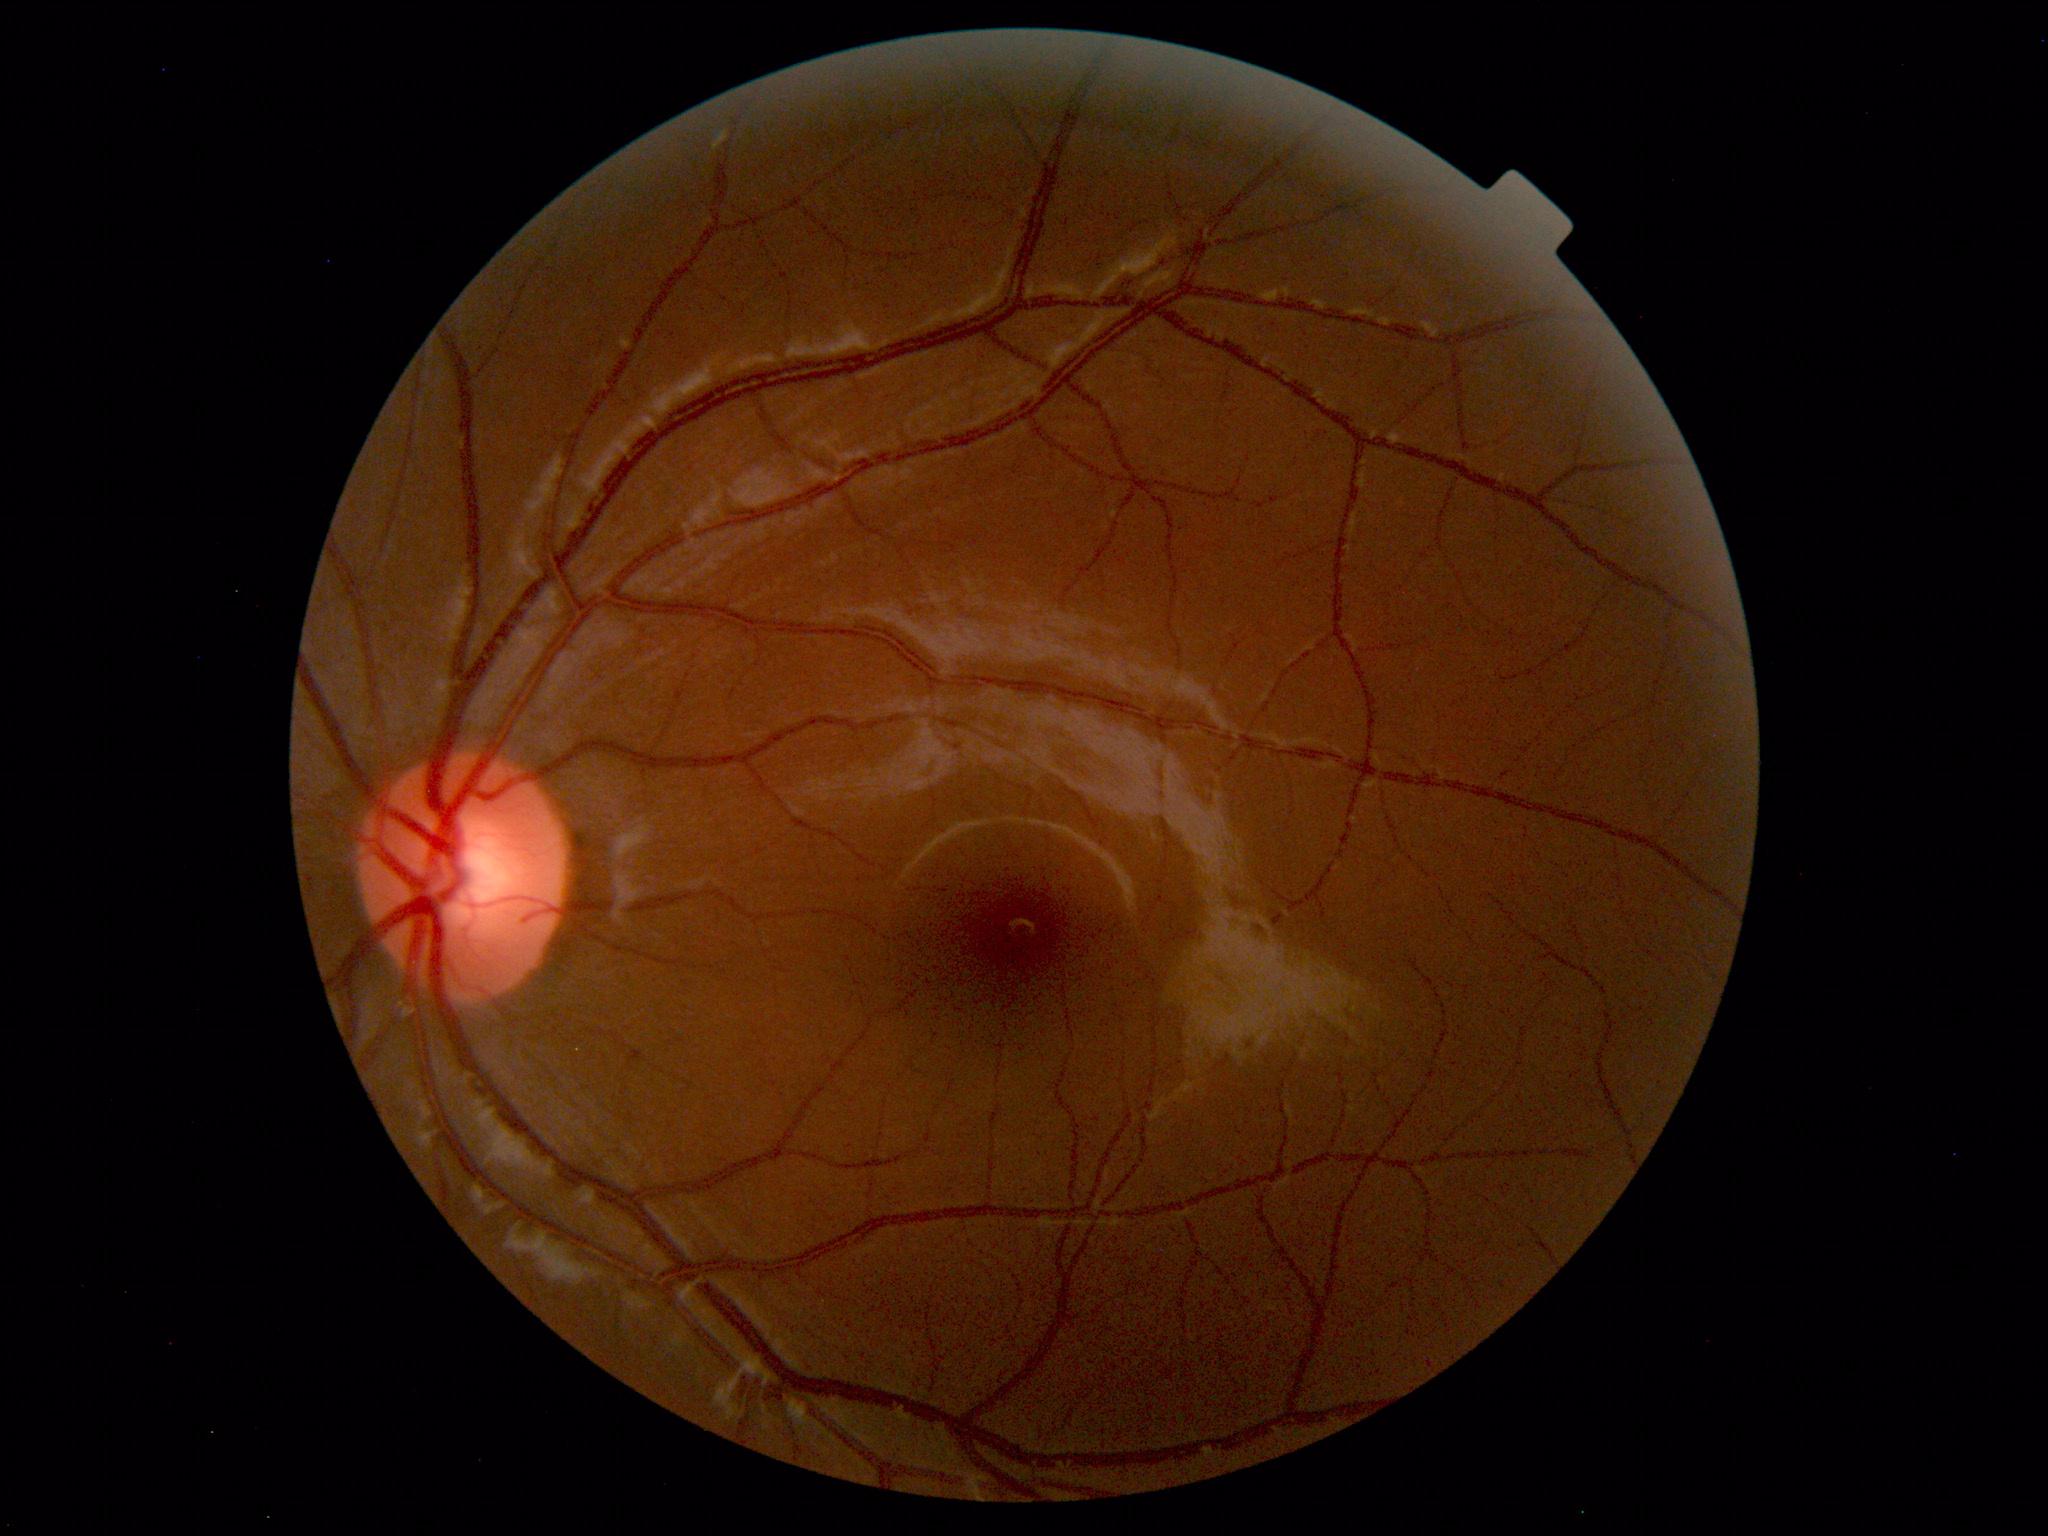 Impression: within normal limits.